Acquired with a NIDEK AFC-230 · 848x848: 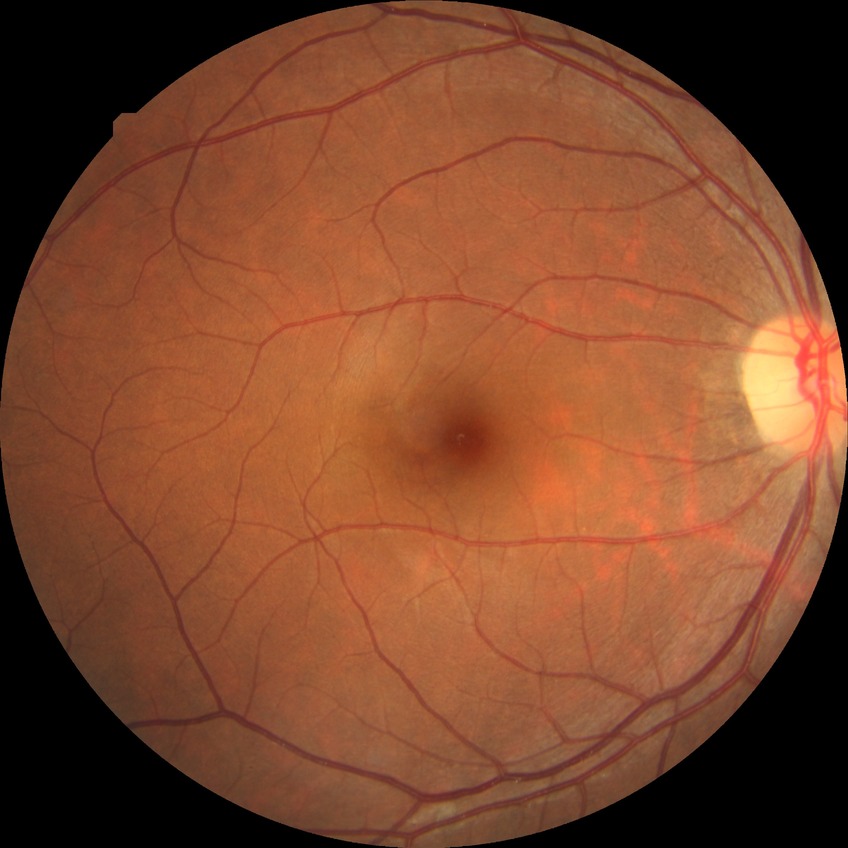

diabetic retinopathy (DR) = NDR (no diabetic retinopathy).